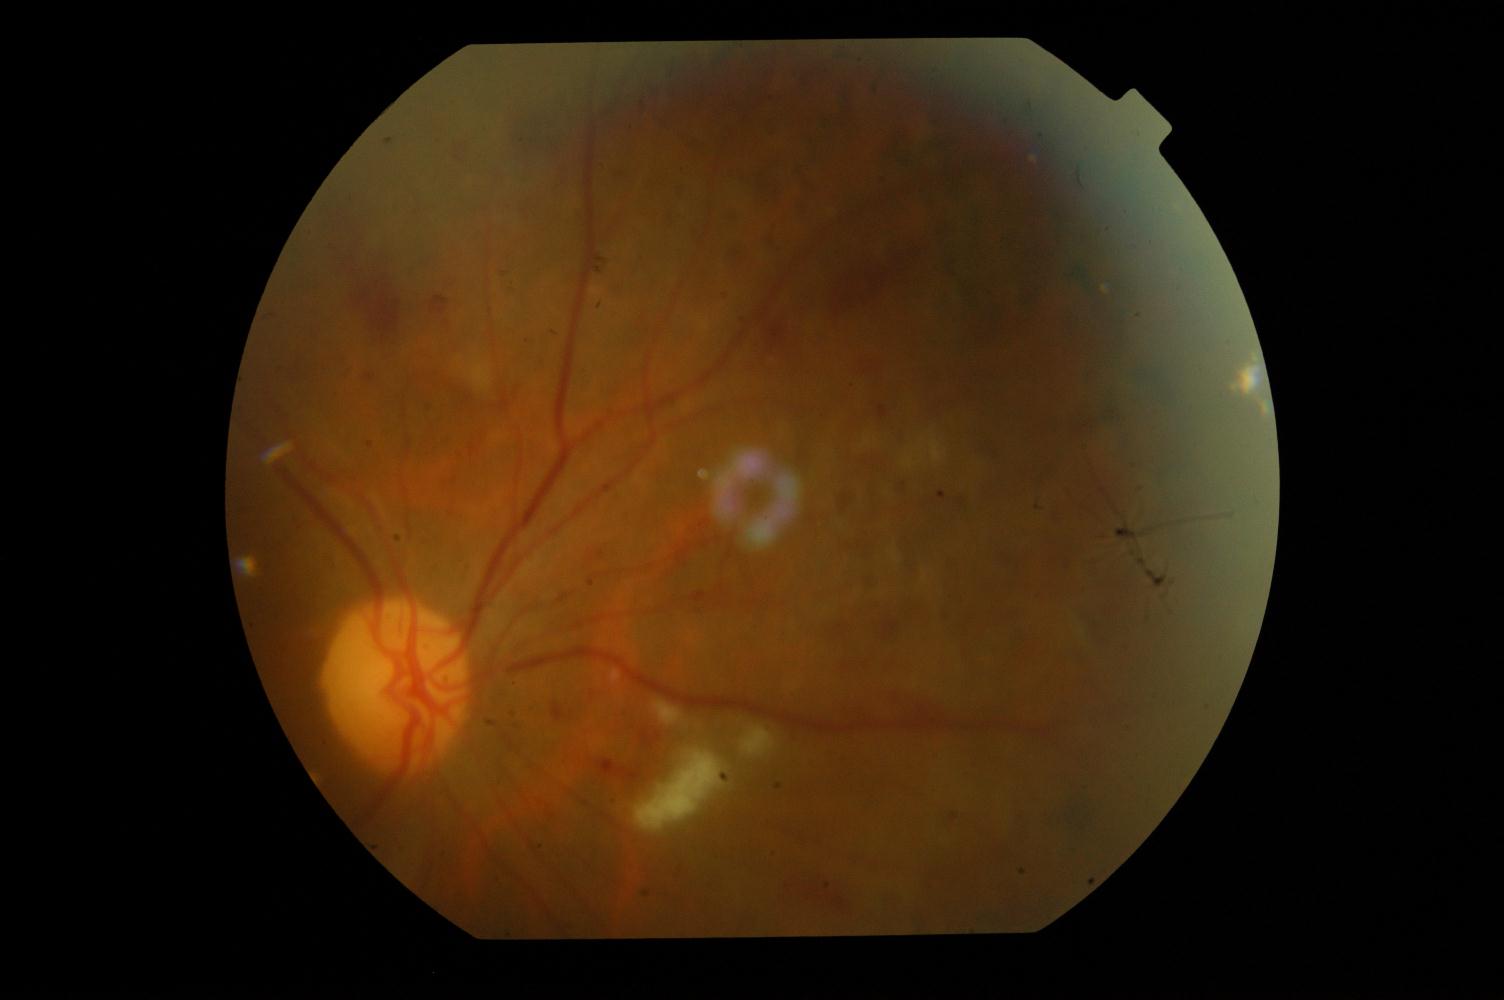

Diagnosis:
- DR (diabetic retinopathy)